CFP — 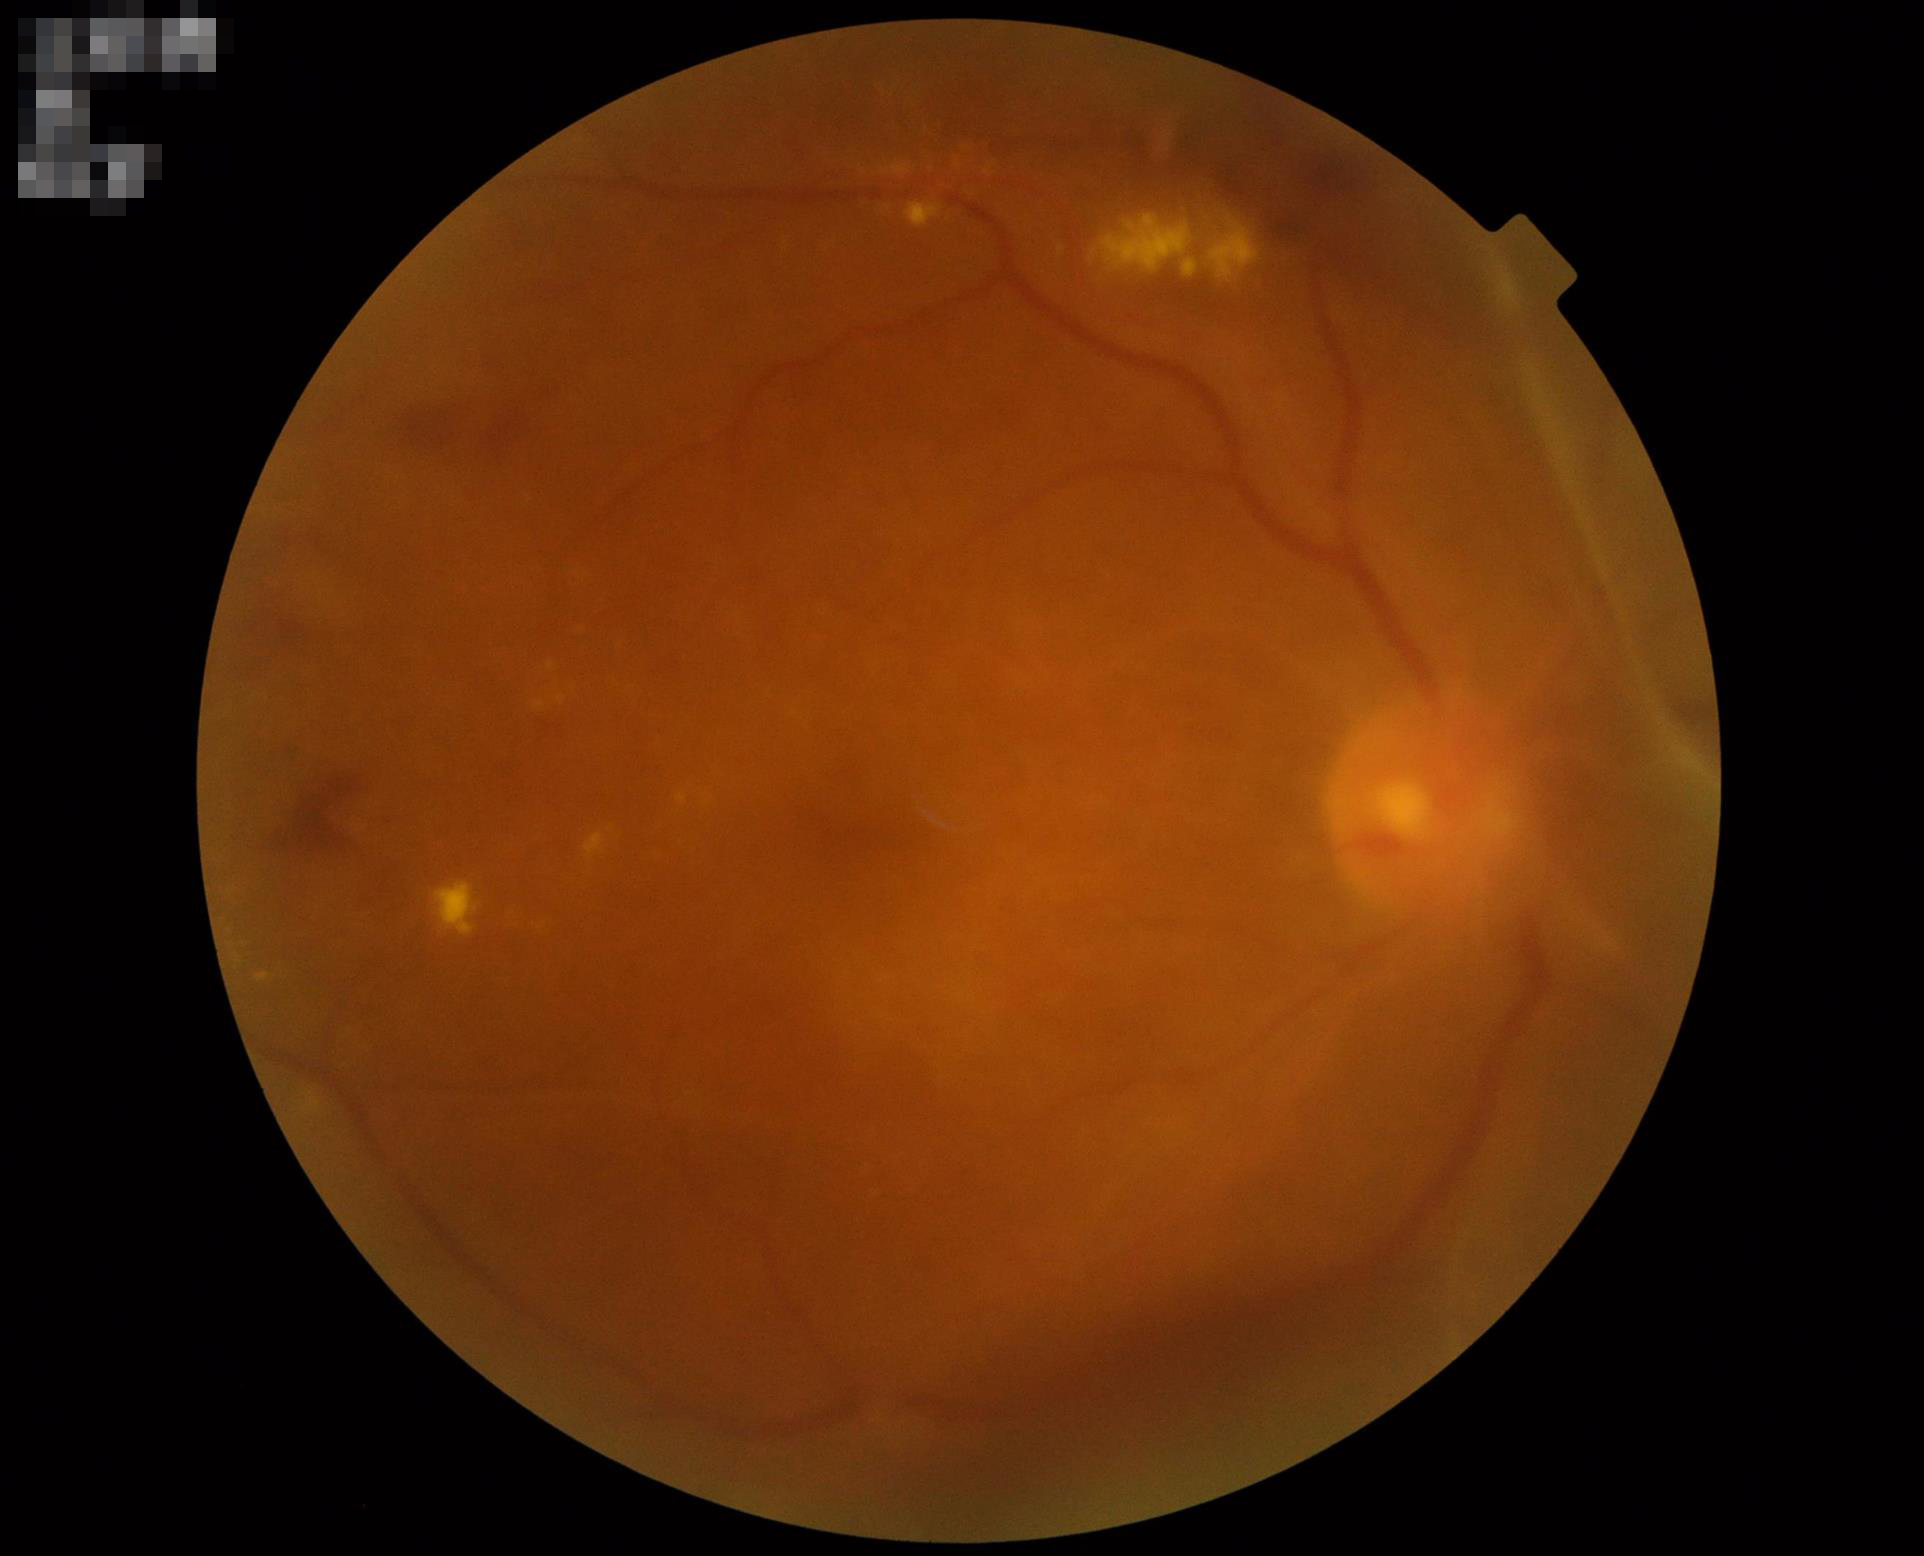

Overall quality is poor; the image is difficult to grade.
Good dynamic range.
Illumination and color balance are good.
The image is blurry.